Diabetic retinopathy graded by the modified Davis classification. 45° field of view. NIDEK AFC-230. No pharmacologic dilation — 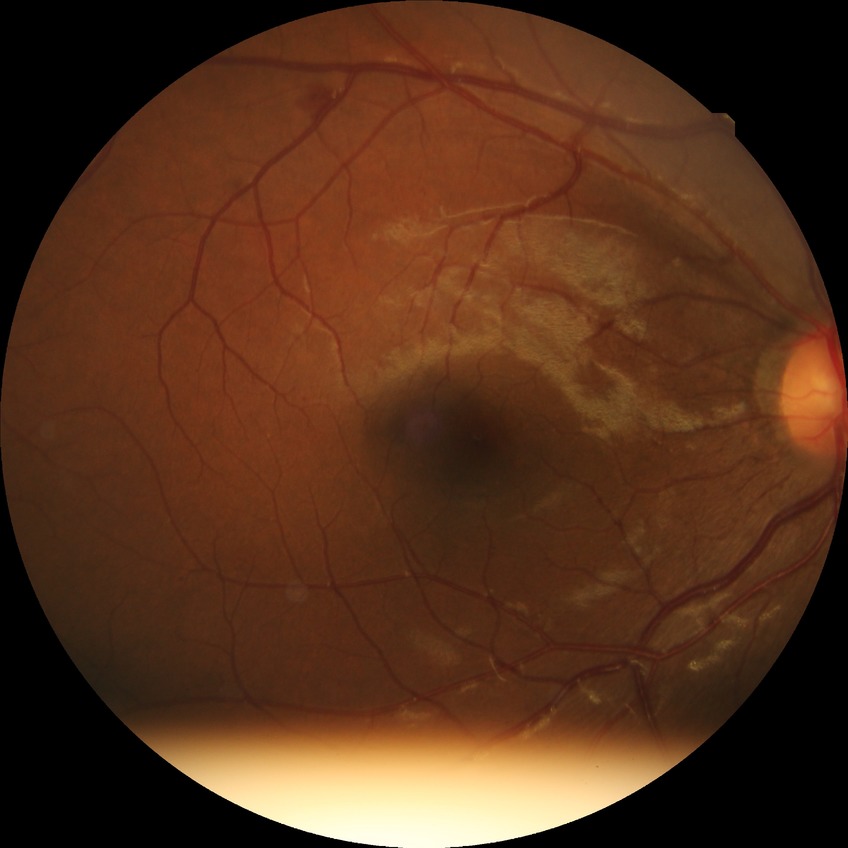

Diabetic retinopathy severity: simple diabetic retinopathy.